45° field of view
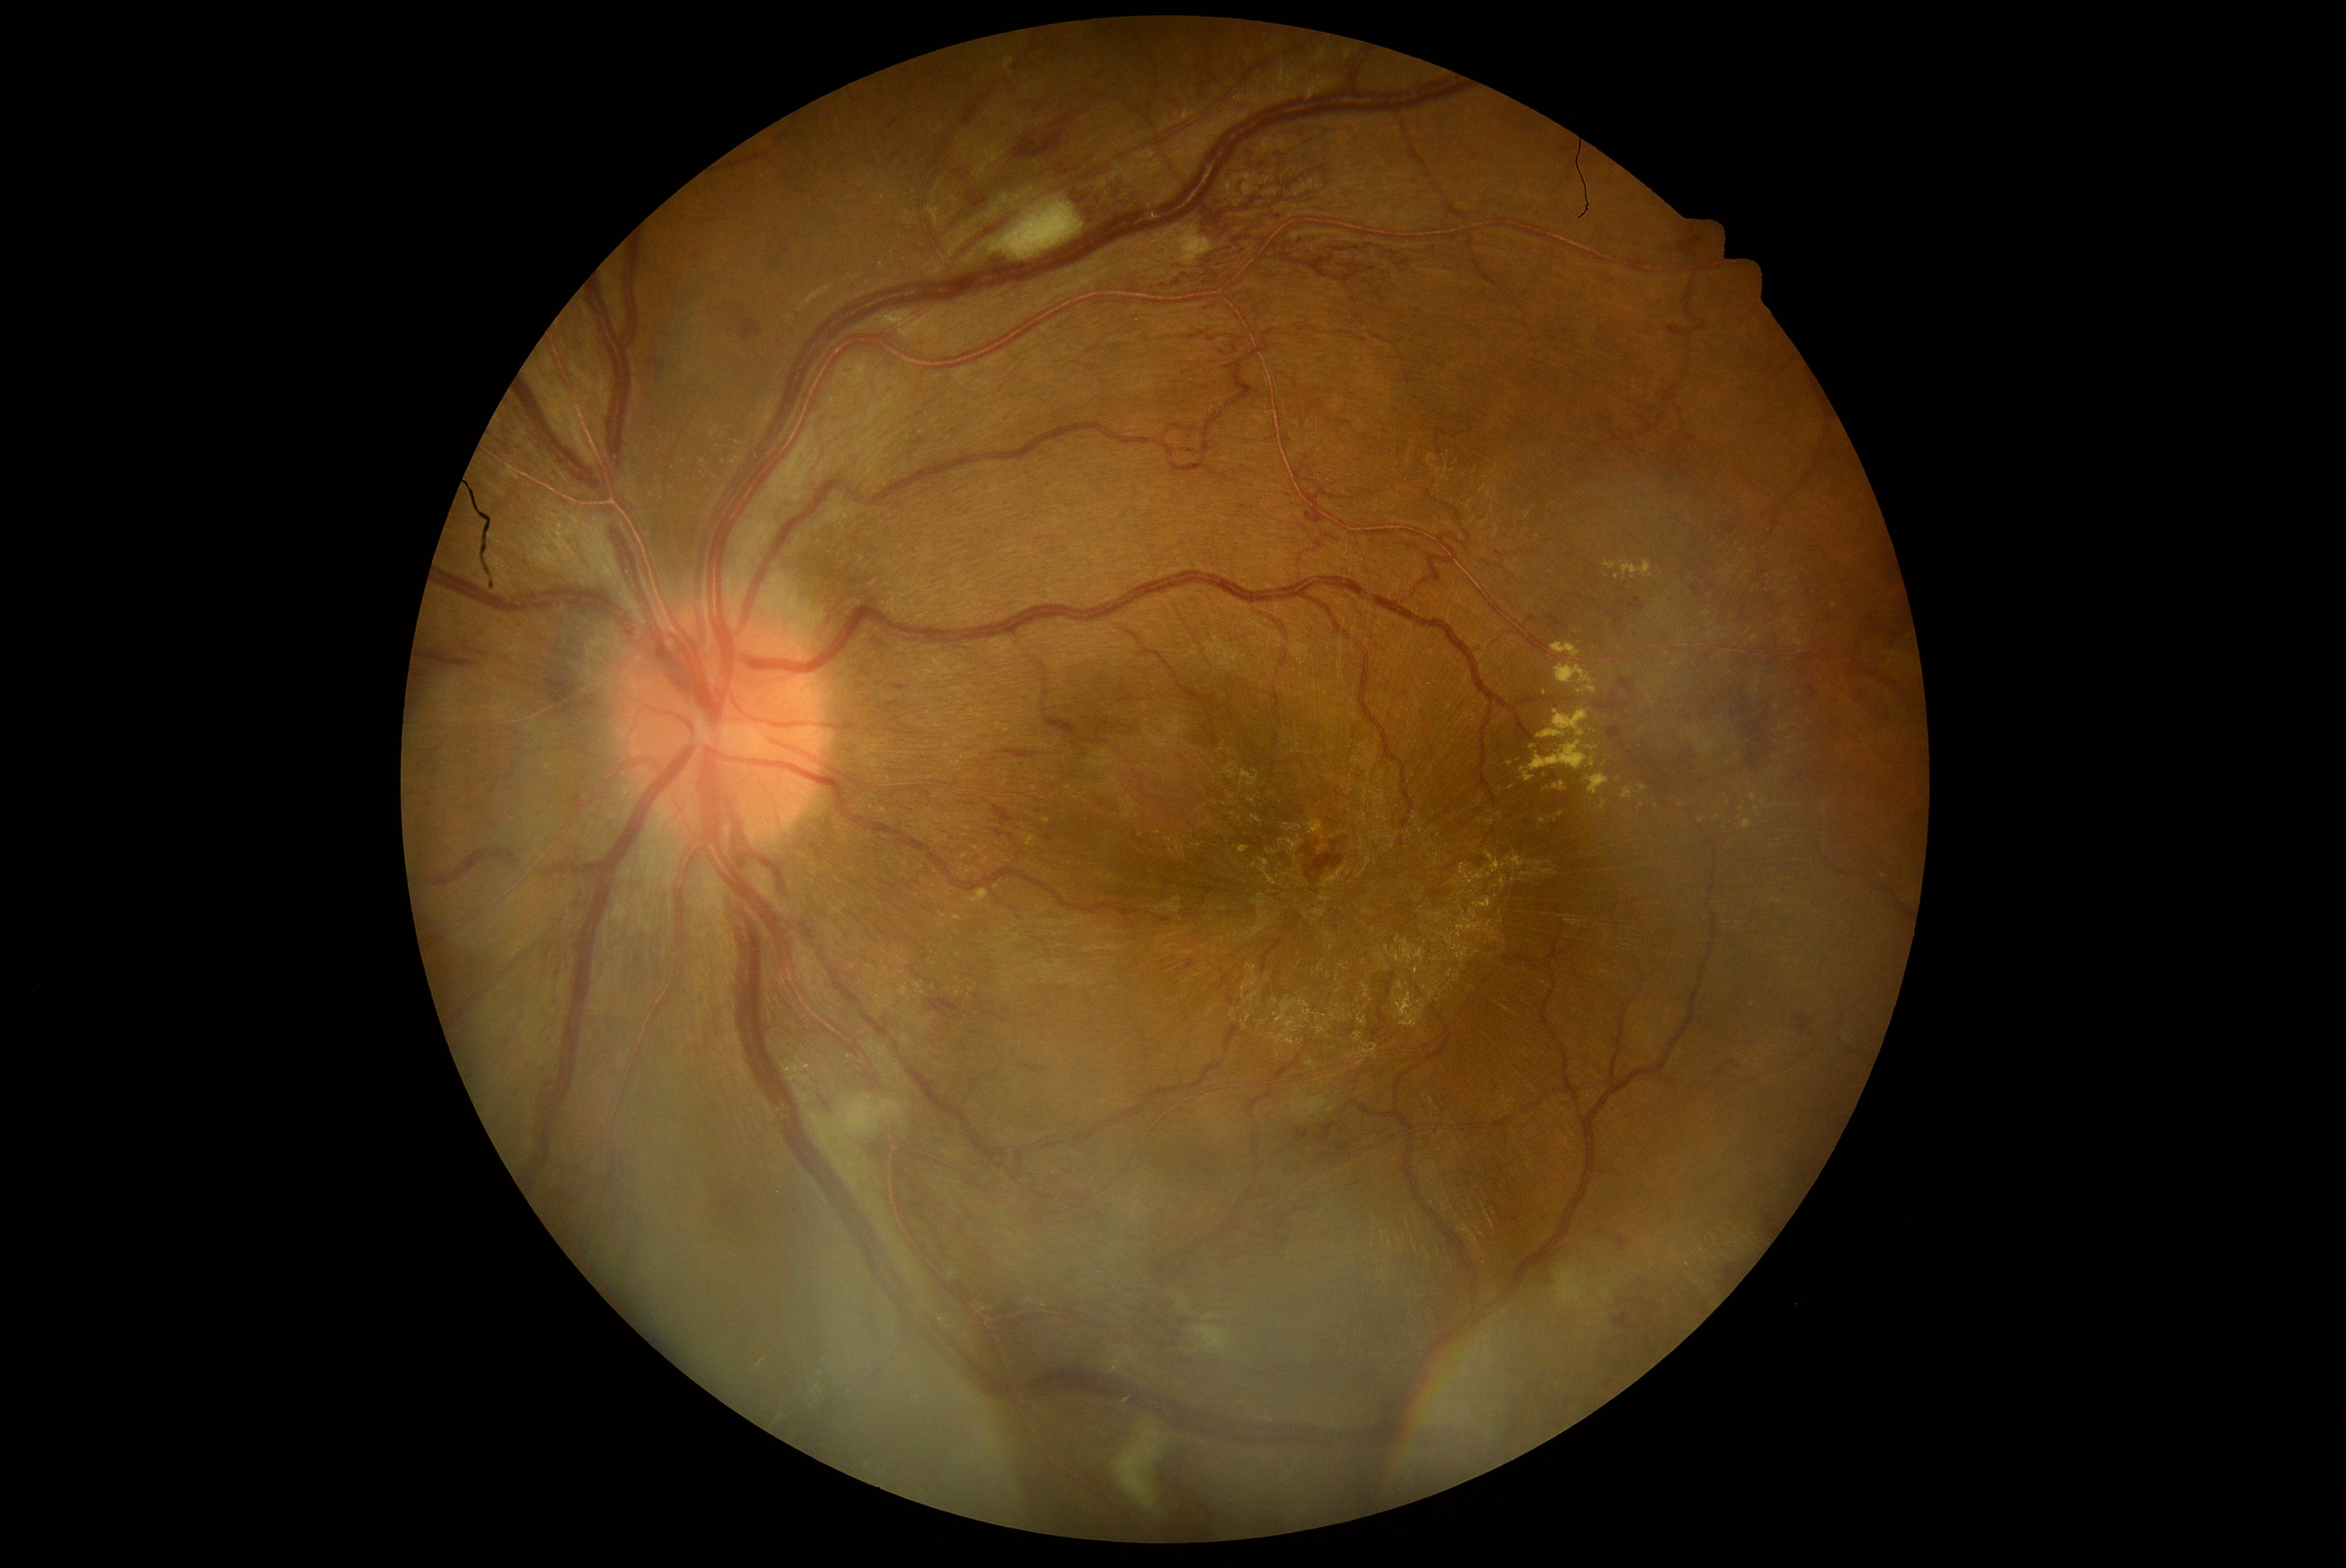
DR: 3/4 — more than 20 intraretinal hemorrhages in each of 4 quadrants, definite venous beading in 2 or more quadrants, or prominent intraretinal microvascular abnormalities in 1 or more quadrants, with no signs of proliferative retinopathy.
EXs include those at x1=1754 y1=808 x2=1760 y2=816; x1=1555 y1=662 x2=1597 y2=694; x1=1603 y1=561 x2=1616 y2=570; x1=1624 y1=788 x2=1636 y2=800; x1=1539 y1=818 x2=1547 y2=826; x1=1552 y1=644 x2=1582 y2=658; x1=1622 y1=561 x2=1654 y2=581; x1=1528 y1=741 x2=1596 y2=772; x1=1586 y1=747 x2=1597 y2=752.
Small EXs approximately at x=1750, y=784; x=1701, y=821; x=1643, y=788; x=1511, y=763; x=1717, y=817; x=1556, y=787.
HEs include those at x1=1594 y1=694 x2=1622 y2=713; x1=1012 y1=129 x2=1066 y2=162; x1=813 y1=1089 x2=835 y2=1117; x1=1059 y1=114 x2=1072 y2=125; x1=1720 y1=675 x2=1790 y2=779; x1=1807 y1=684 x2=1818 y2=700; x1=1000 y1=749 x2=1039 y2=760; x1=1608 y1=728 x2=1622 y2=742; x1=1232 y1=98 x2=1252 y2=111; x1=928 y1=1000 x2=961 y2=1017; x1=1619 y1=741 x2=1627 y2=749; x1=959 y1=1044 x2=968 y2=1053; x1=978 y1=1001 x2=1012 y2=1025; x1=1332 y1=1142 x2=1351 y2=1160.
Small HEs approximately at x=968, y=173; x=1042, y=106; x=1714, y=703; x=1342, y=1132; x=1643, y=608; x=954, y=225.